640x480 · pediatric wide-field fundus photograph
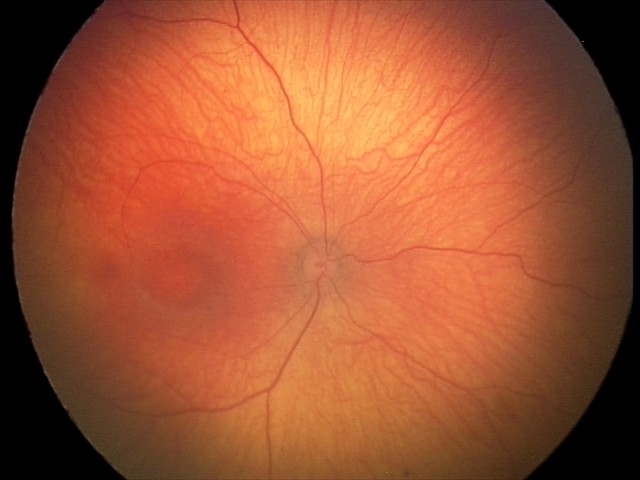

Screening examination with no abnormal retinal findings.